Image size 2089x1764:
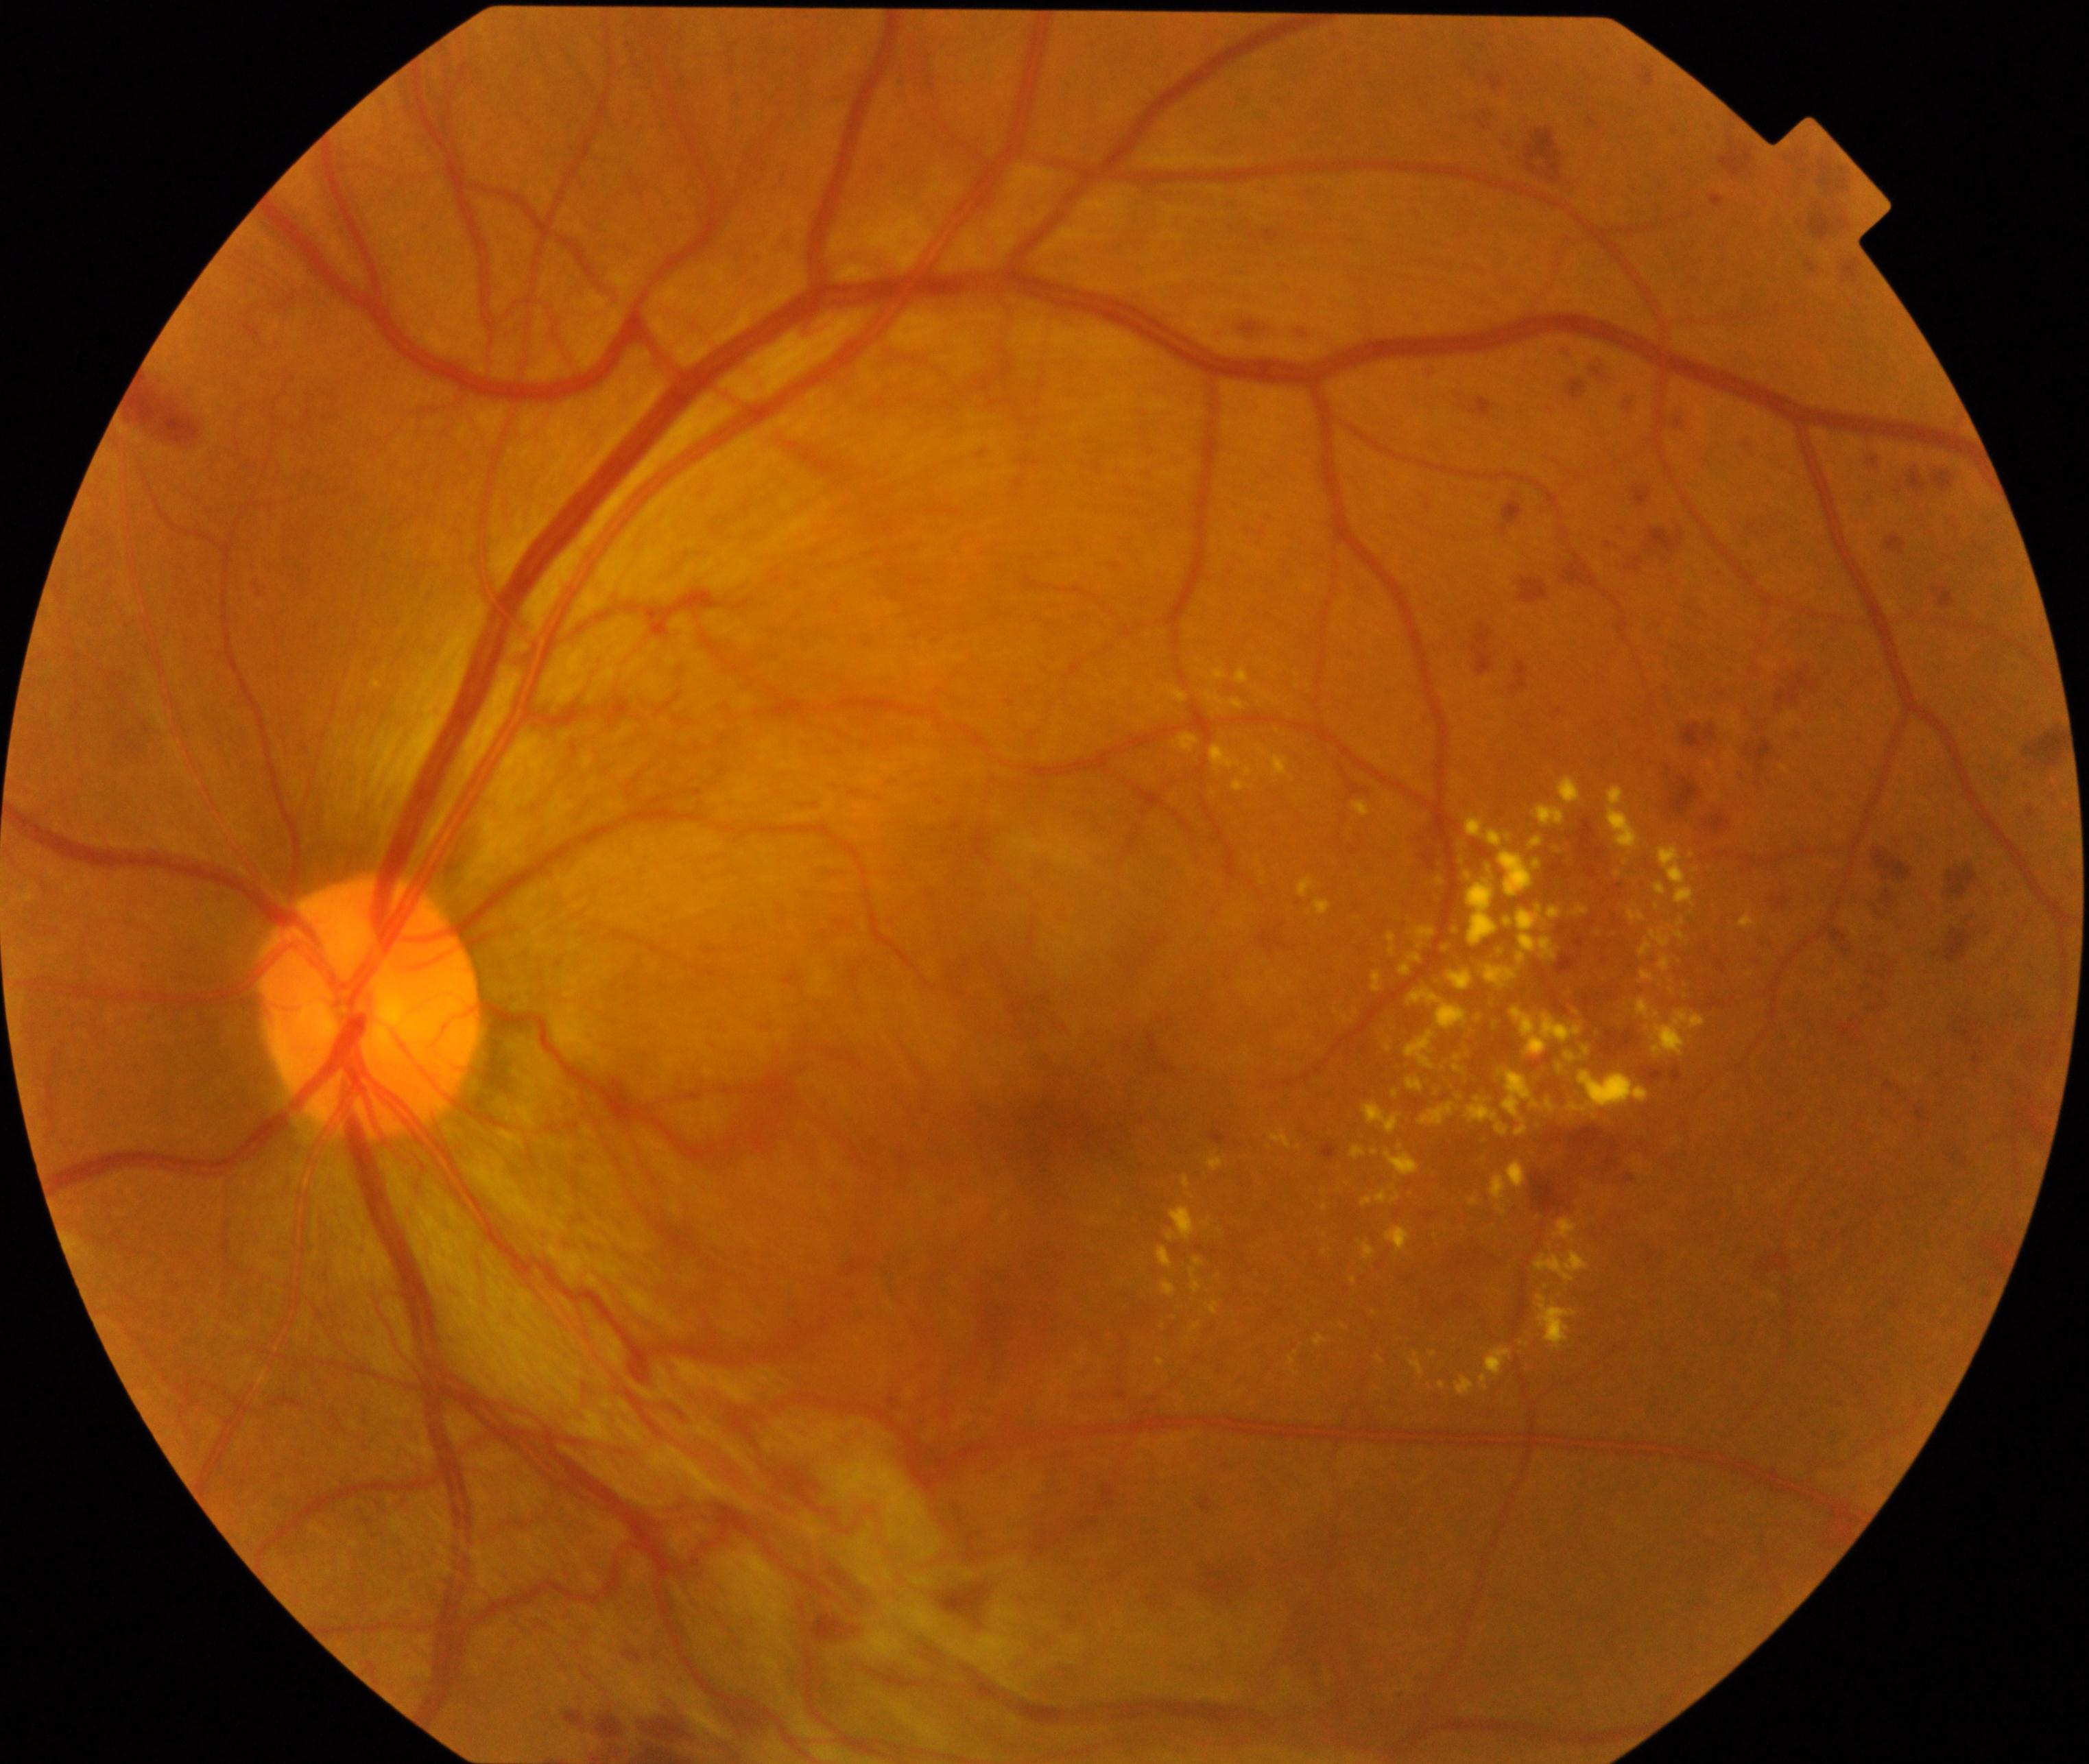 Findings: severe non-proliferative or proliferative diabetic retinopathy.